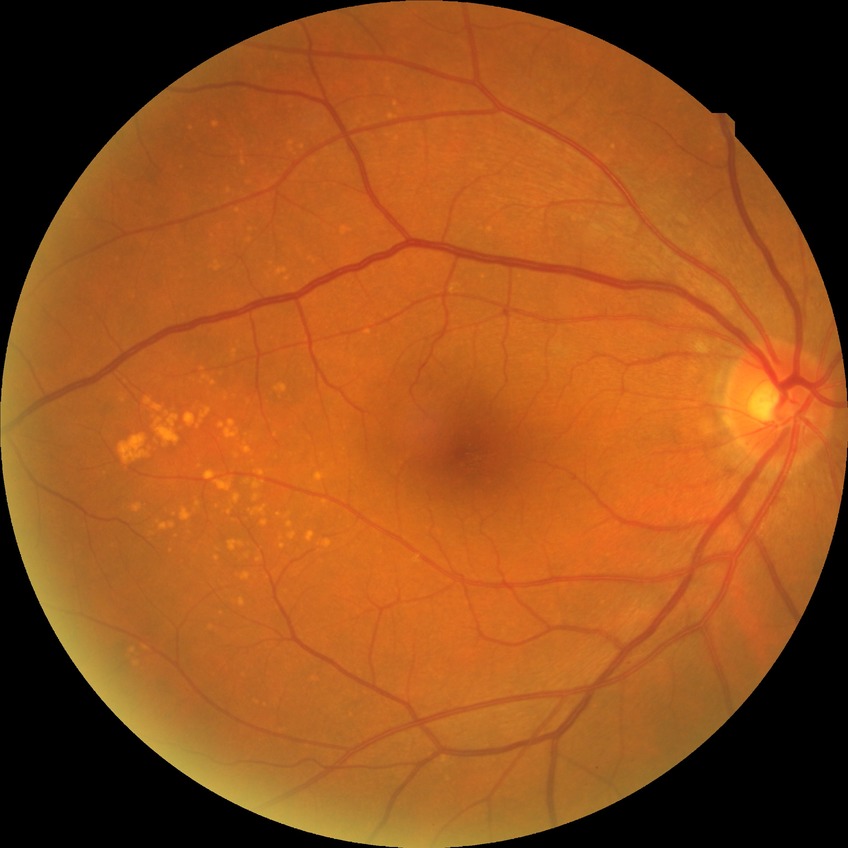 modified Davis grading: no diabetic retinopathy.